CFP · 2361 by 1568 pixels · camera: Kowa VX-10α.
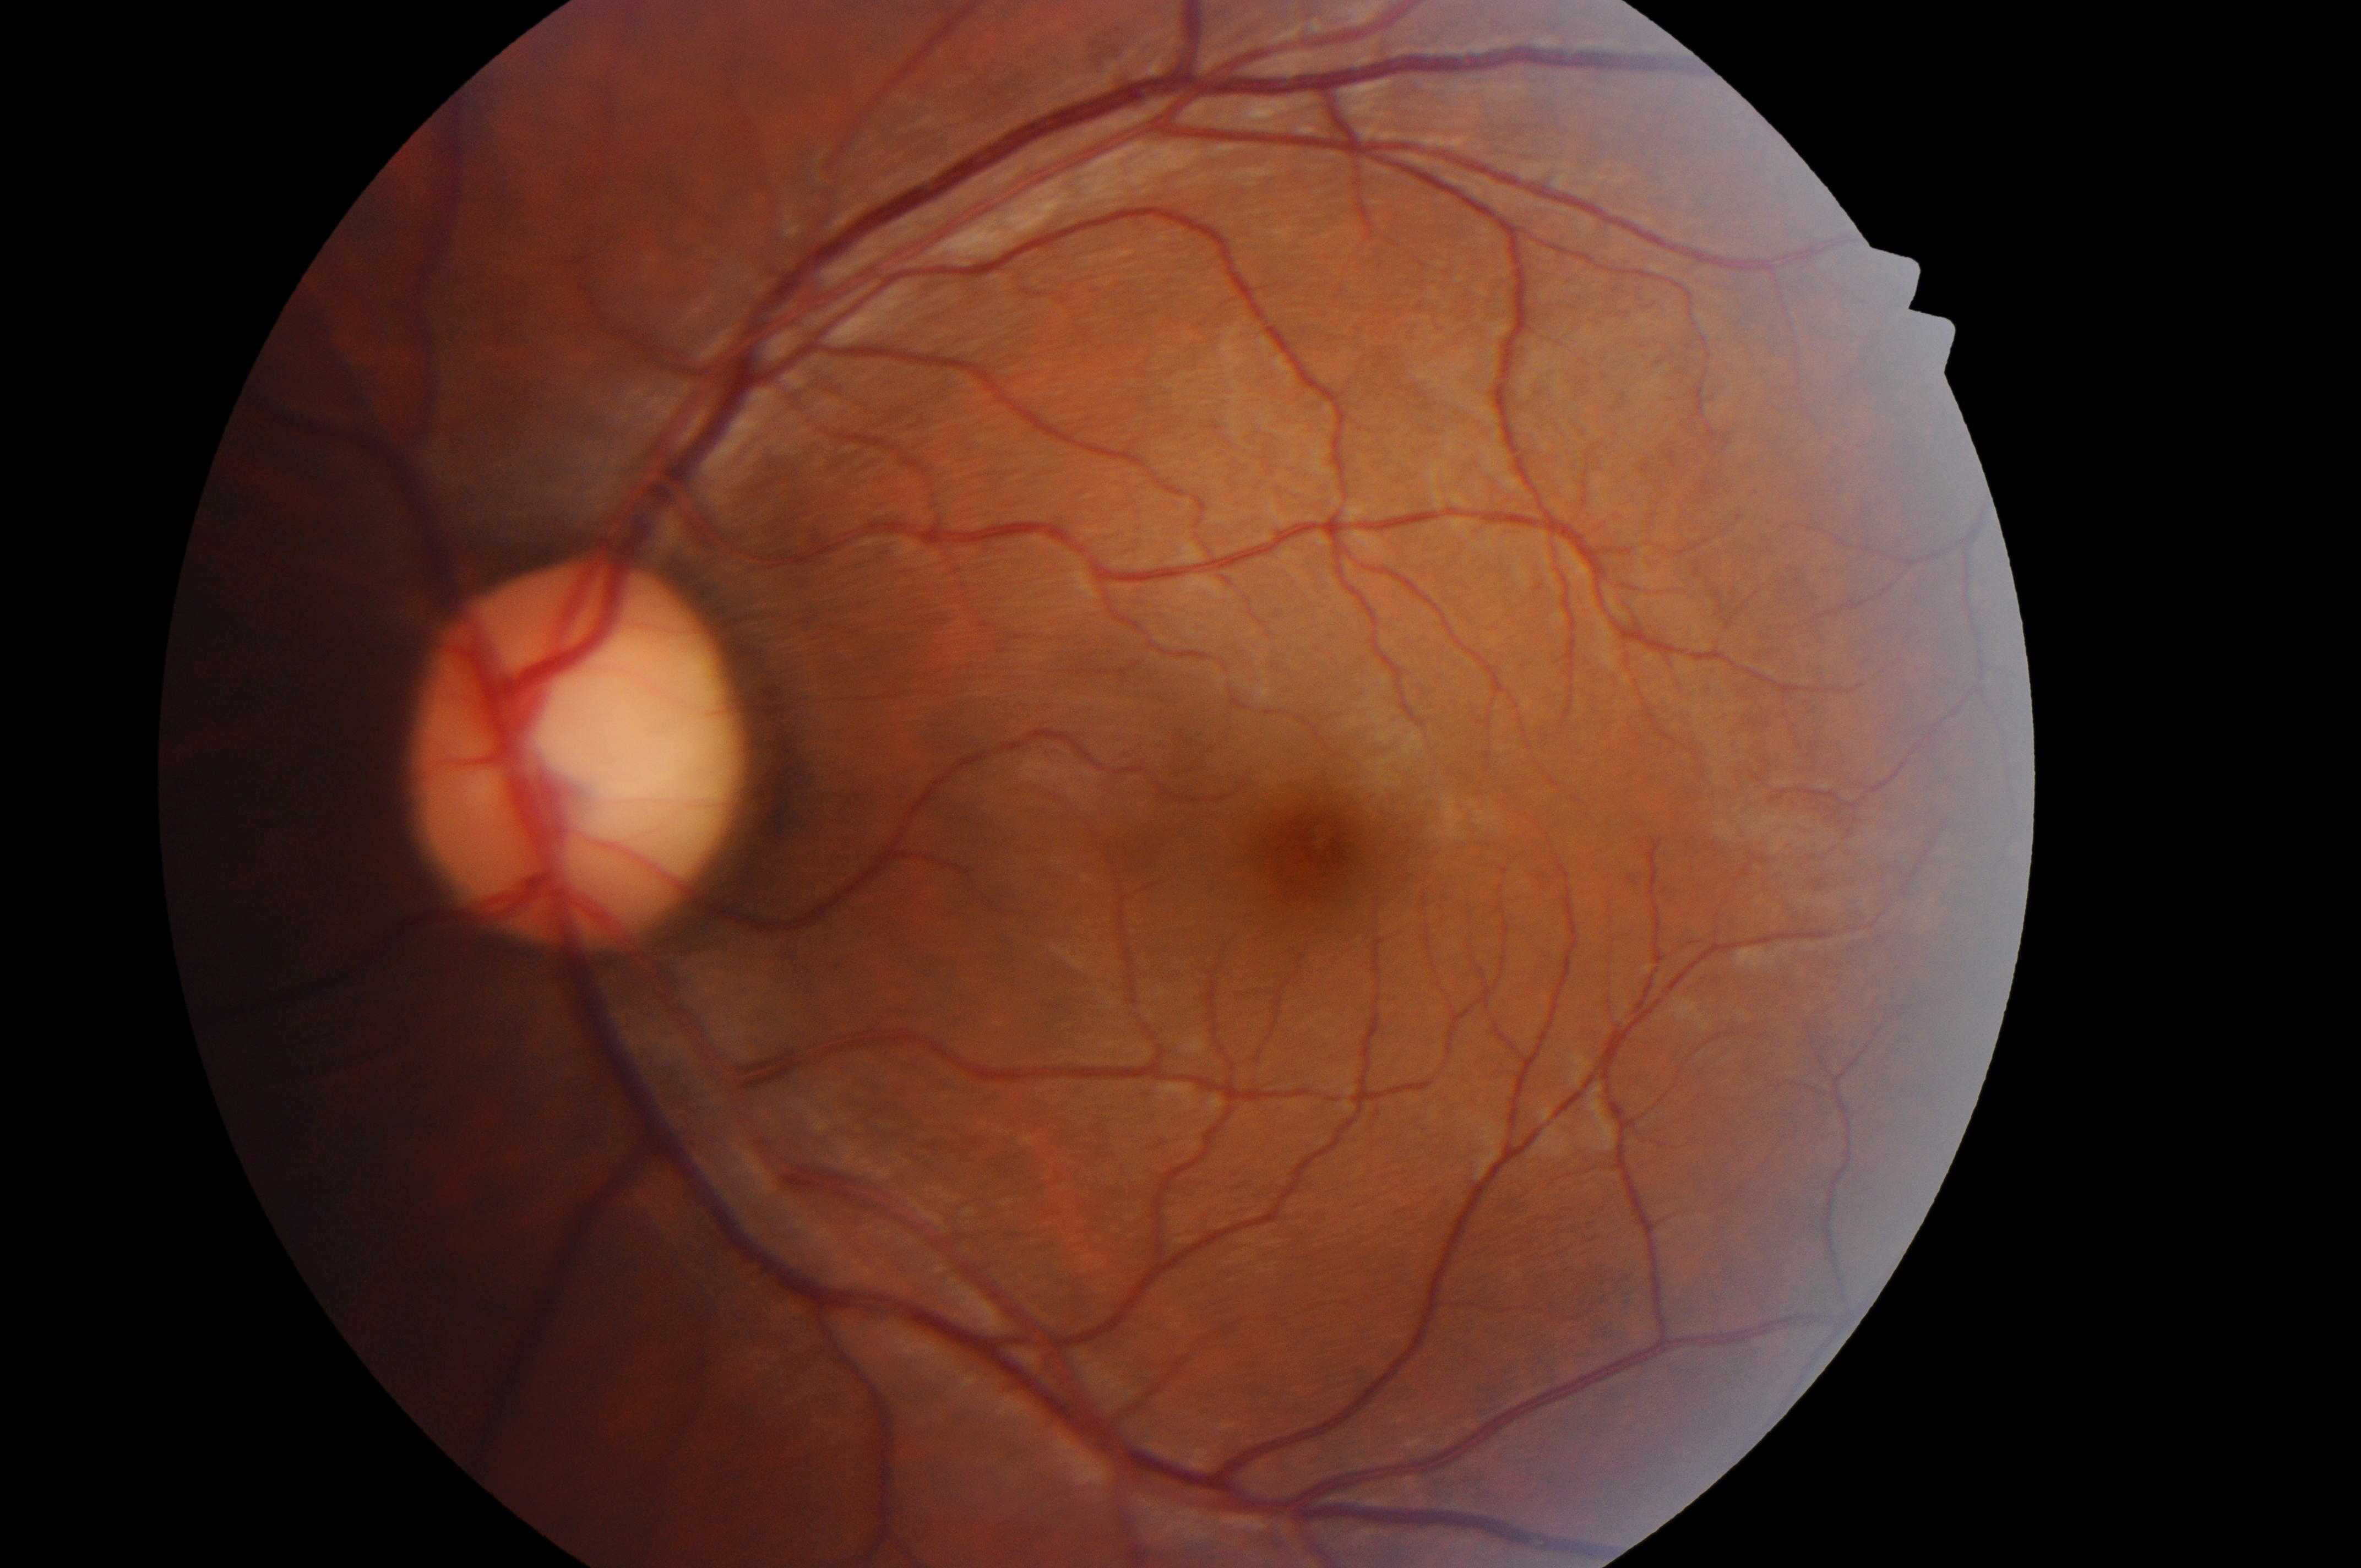

laterality: the left eye
retinopathy grade: 0 (no apparent retinopathy) — no visible signs of diabetic retinopathy
fovea center: [1314, 856]
risk of macular edema: no risk (grade 0) — no apparent hard exudates
ONH: [565, 765]